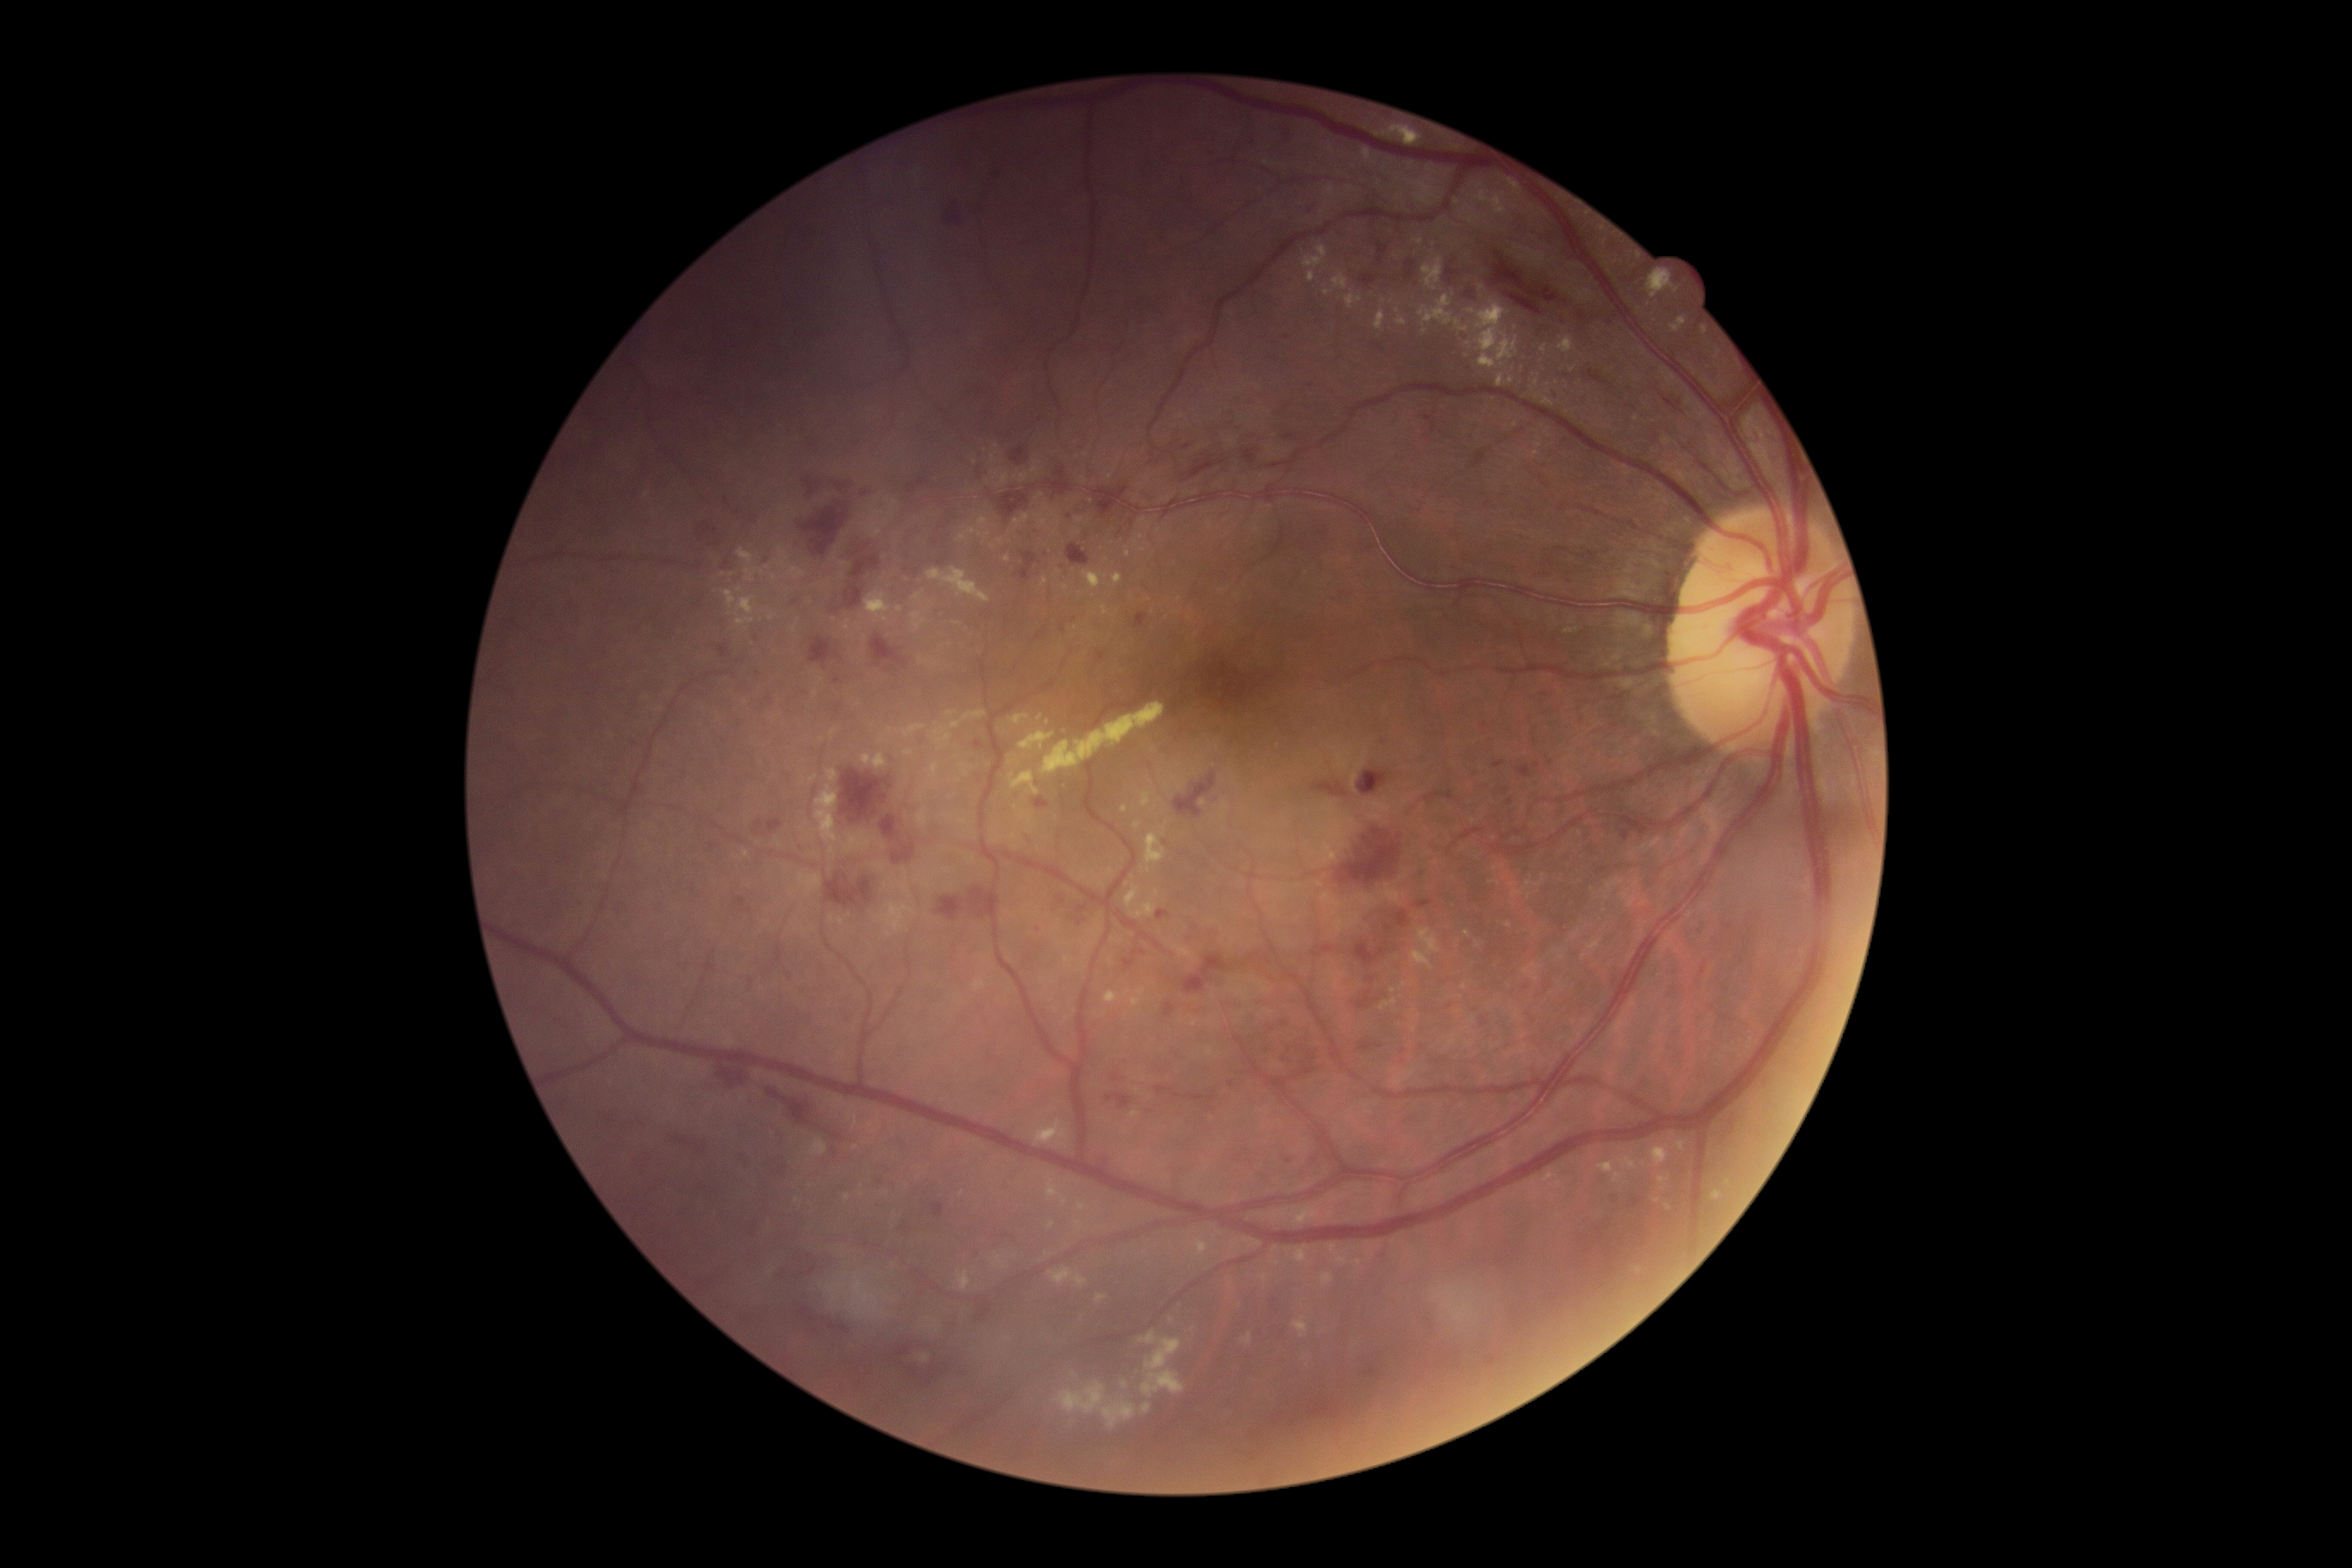
Findings:
* DR: grade 3 (severe NPDR)